Infant wide-field fundus photograph:
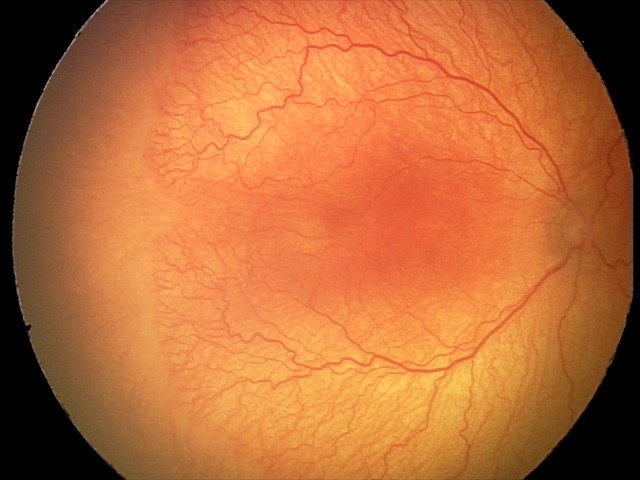
Q: What is the screening diagnosis?
A: aggressive retinopathy of prematurity (A-ROP)